2212x1659:
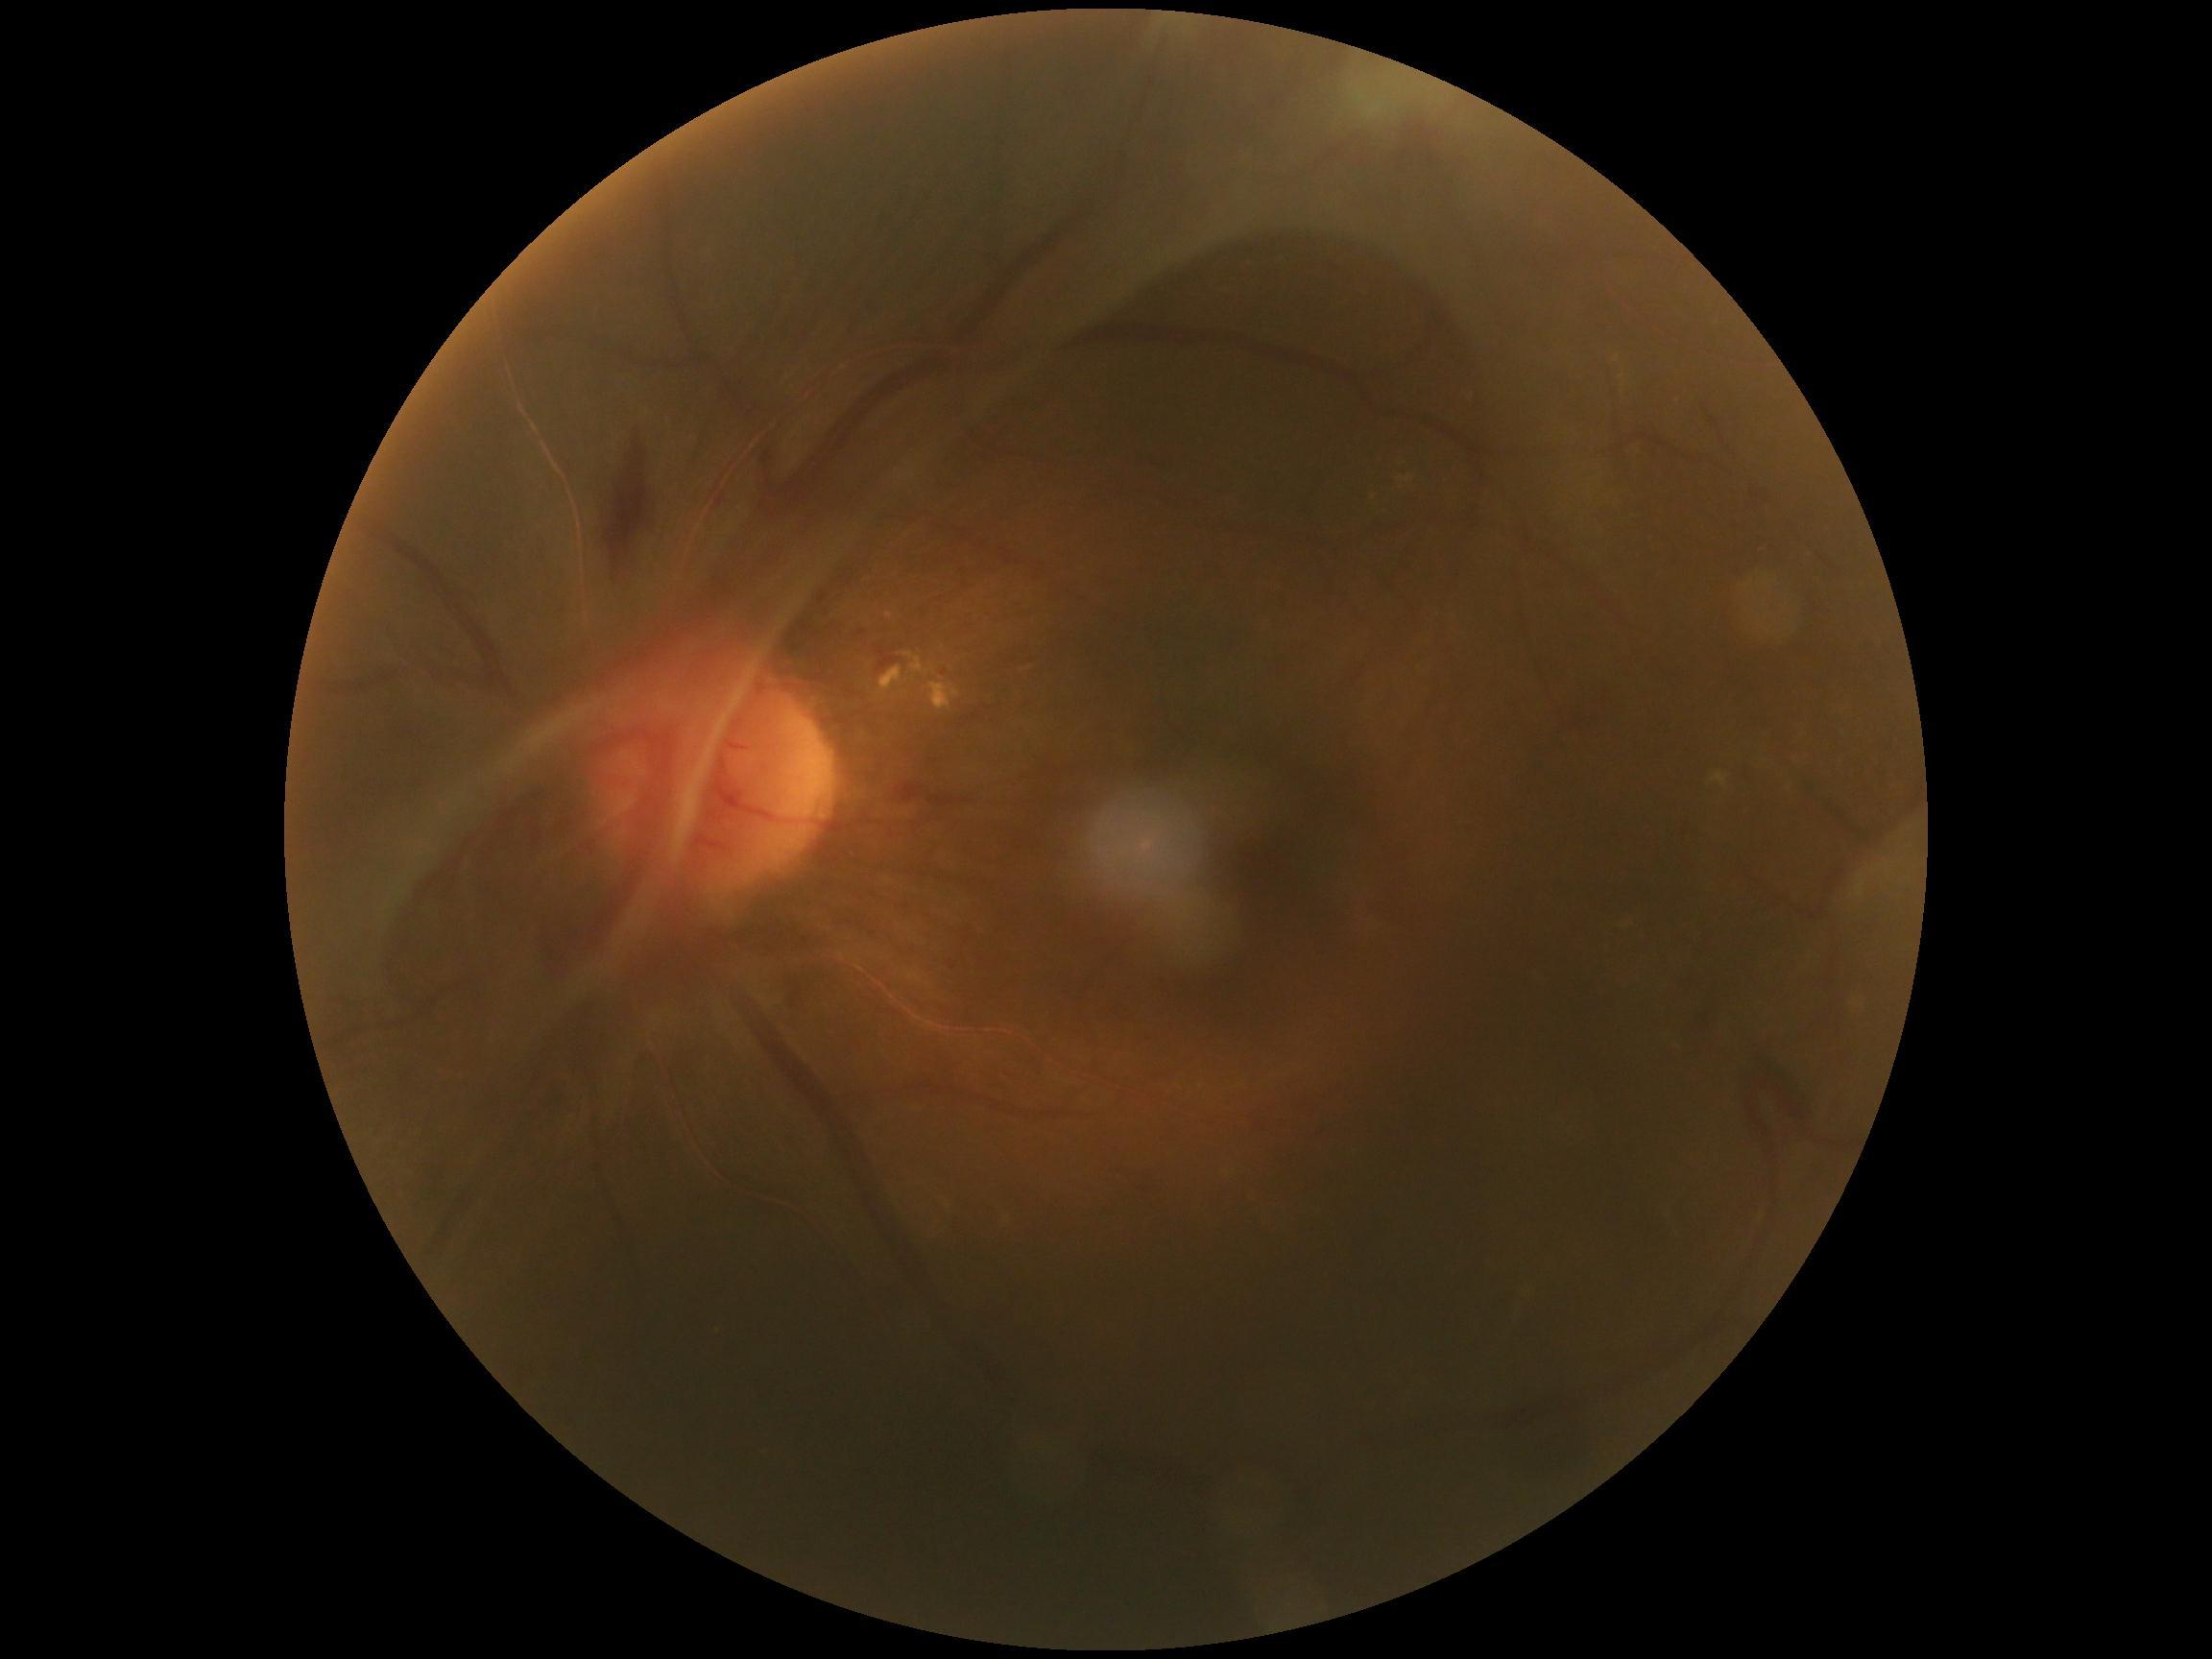 DR grade is 4/4 — neovascularization and/or vitreous/pre-retinal hemorrhage.